Retinal fundus photograph: 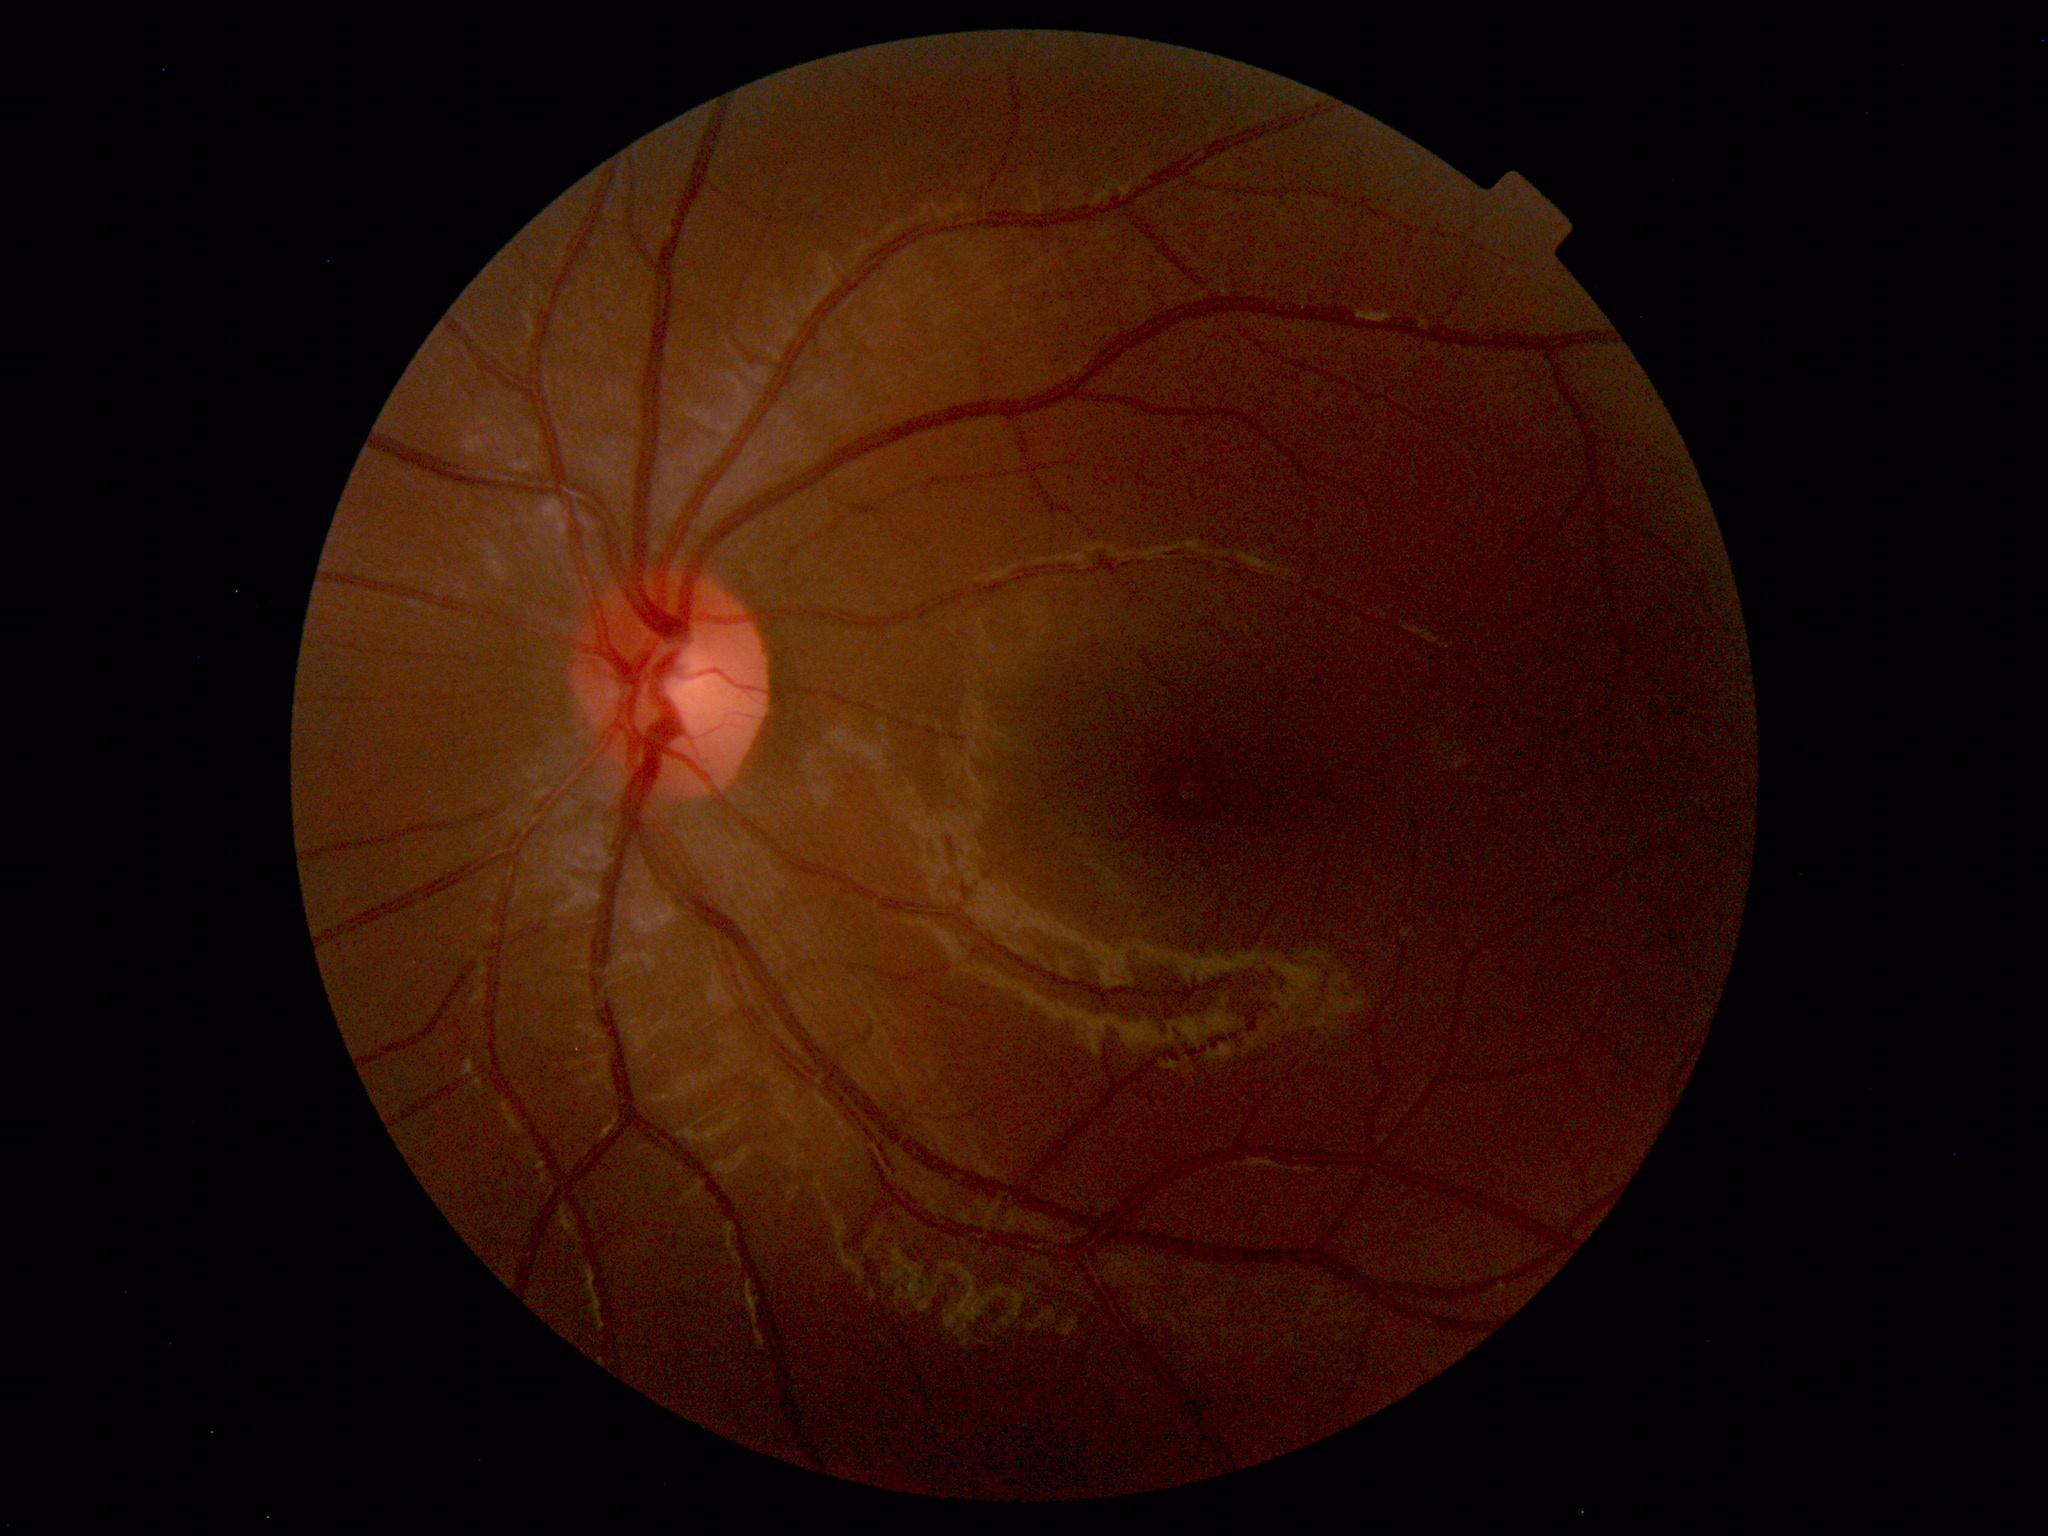
Normal fundus appearance.